2352x1568px; CFP: 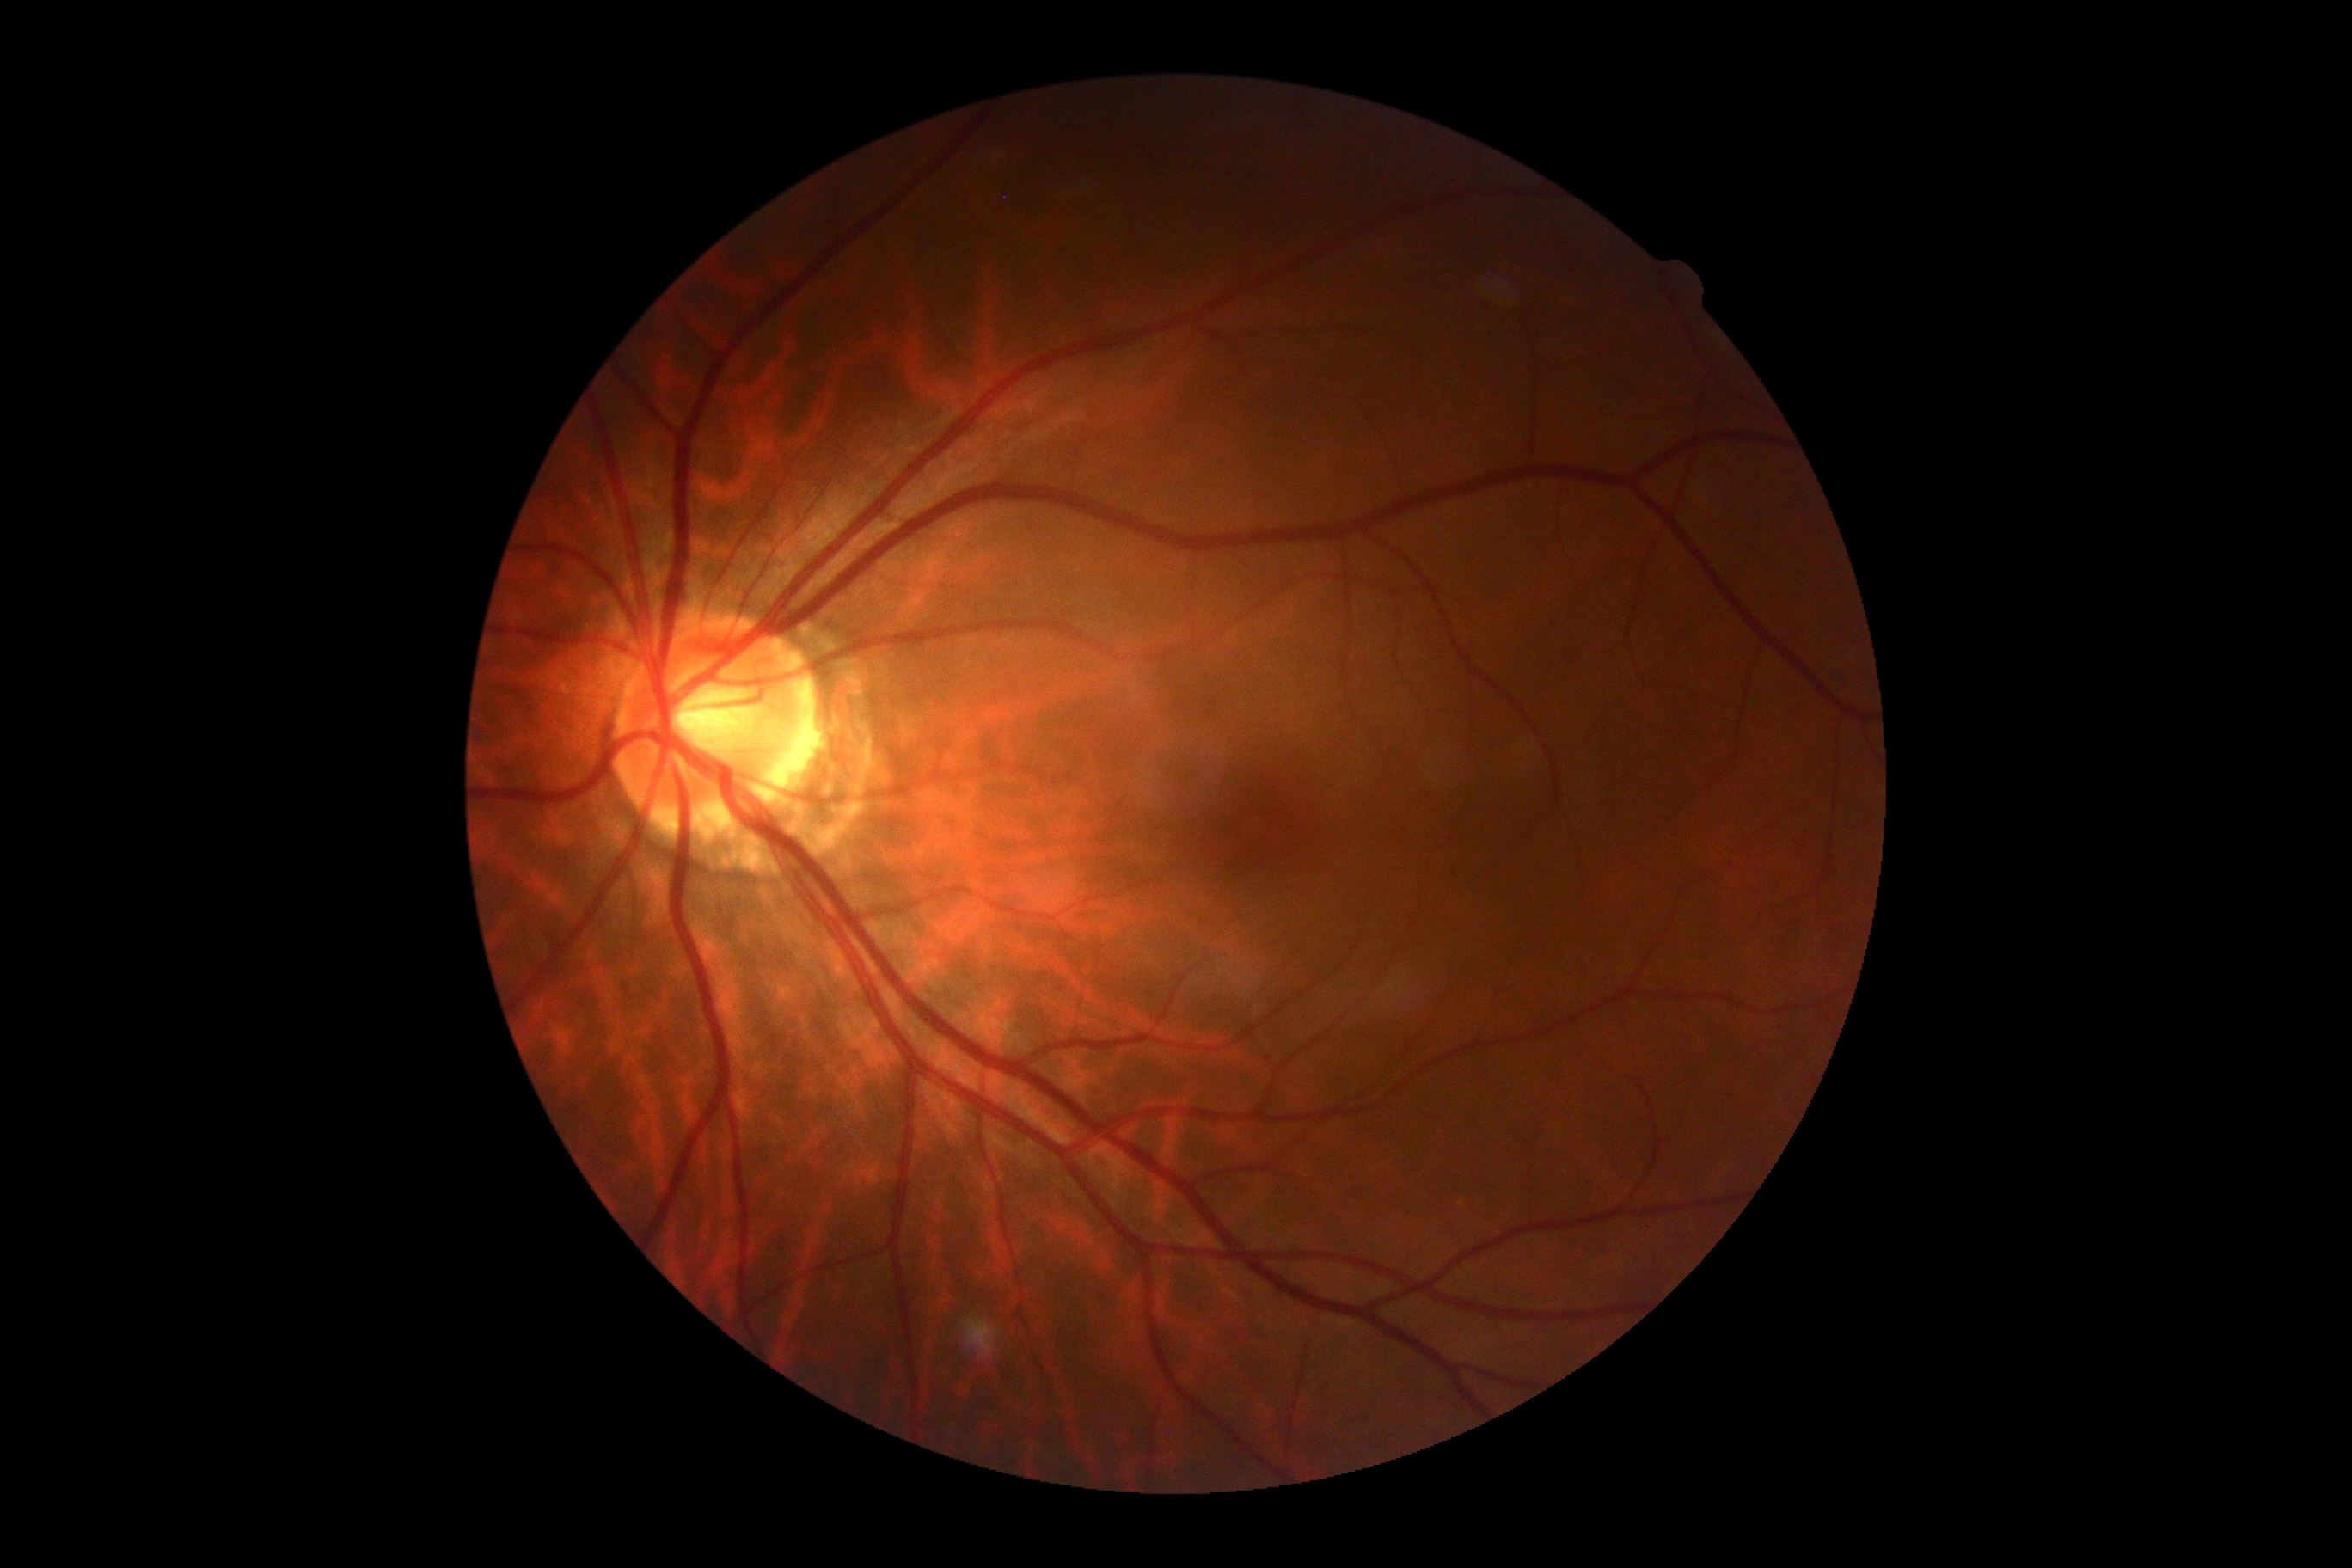

diabetic retinopathy grade = no apparent diabetic retinopathy (0); DR impression = no signs of DR.